Wide-field fundus image from infant ROP screening:
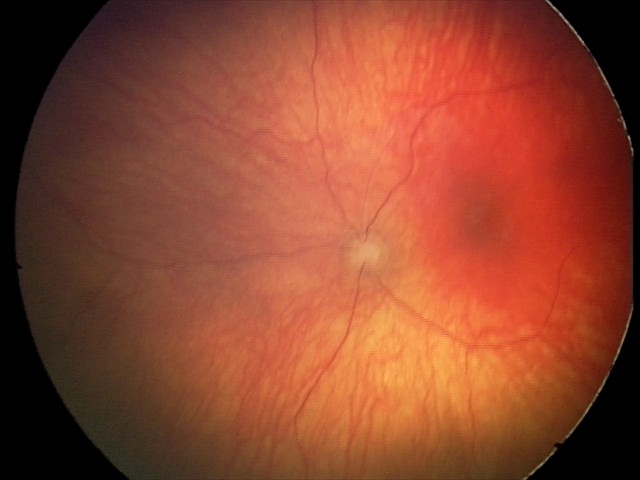 Assessment = optic nerve hypoplasia.